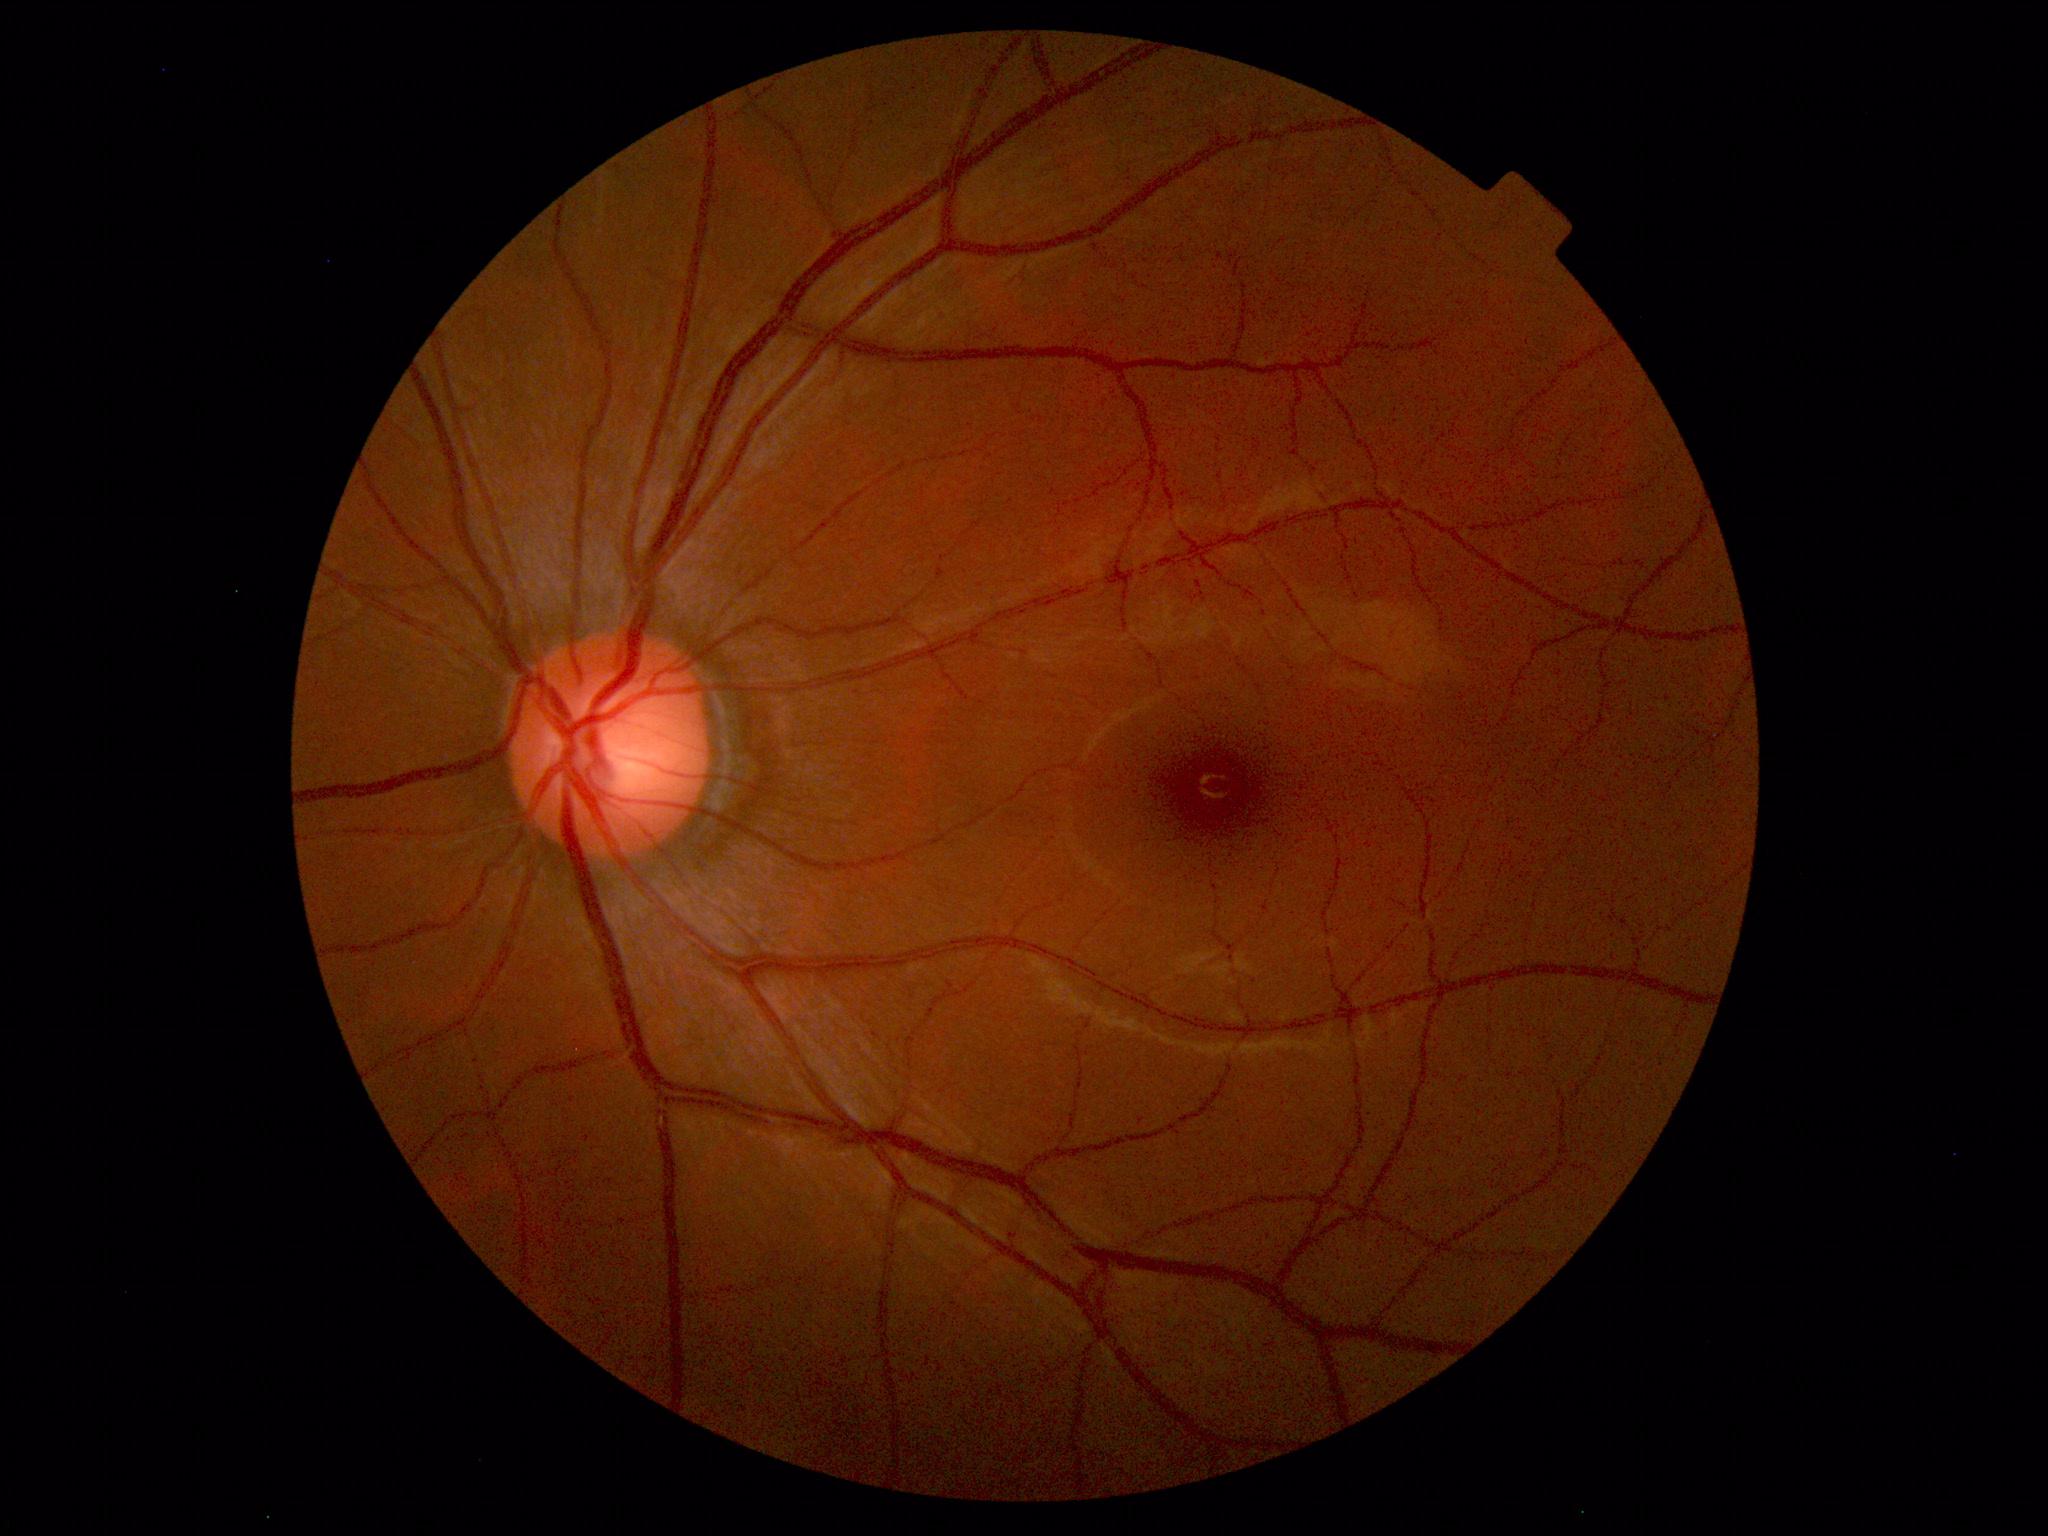

Findings: no abnormalities.